DR severity per modified Davis staging: 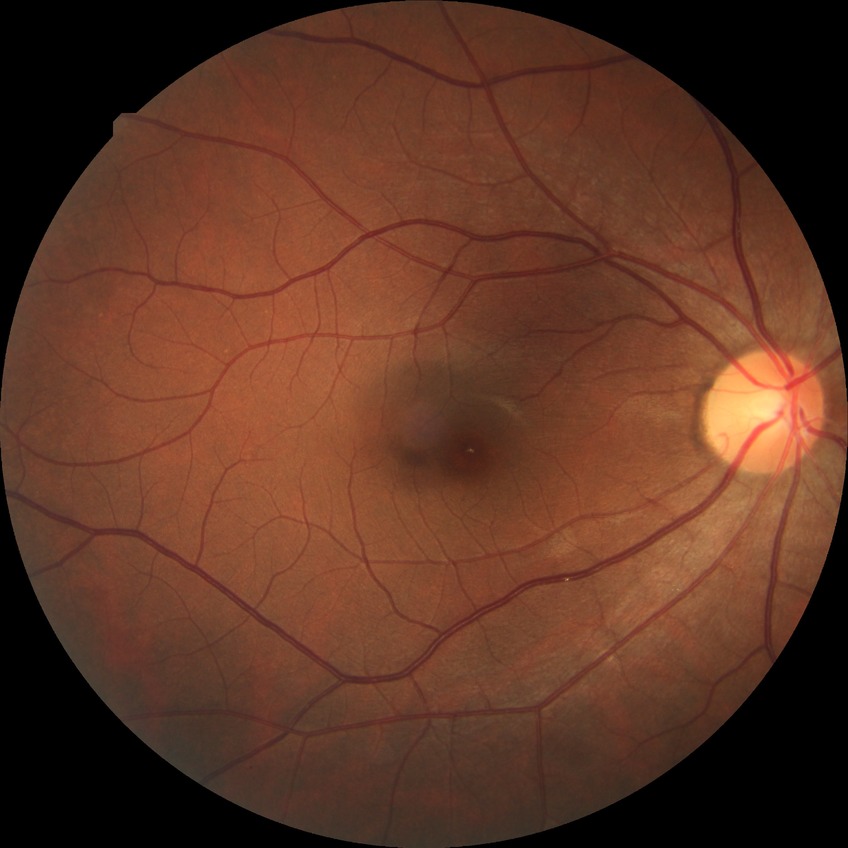 DR = NDR; DR impression = negative for DR.